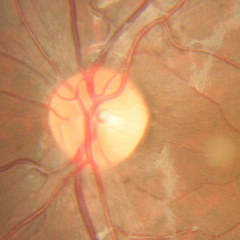

No glaucomatous changes.